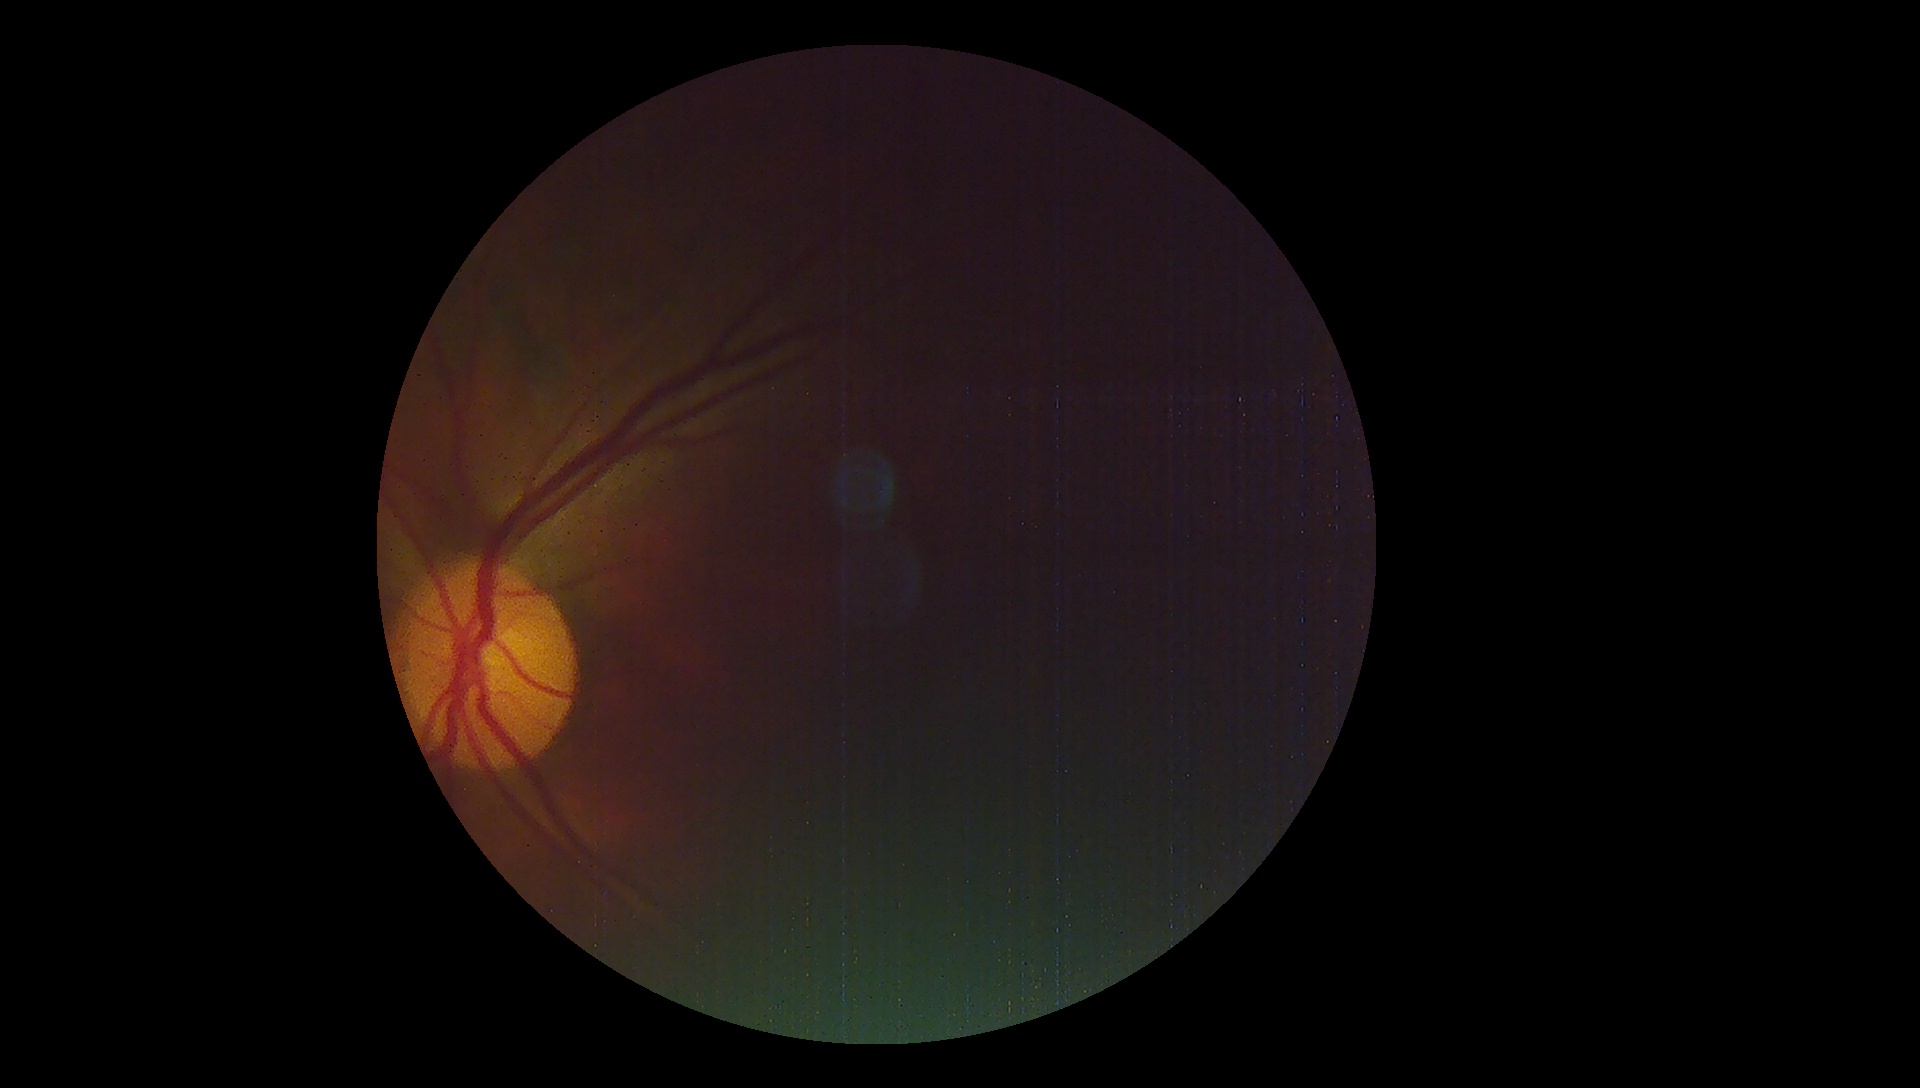 Quality too poor to assess for DR. Diabetic retinopathy: ungradable.